FOV: 45 degrees, acquired with a NIDEK AFC-230, 848x848, Davis DR grading:
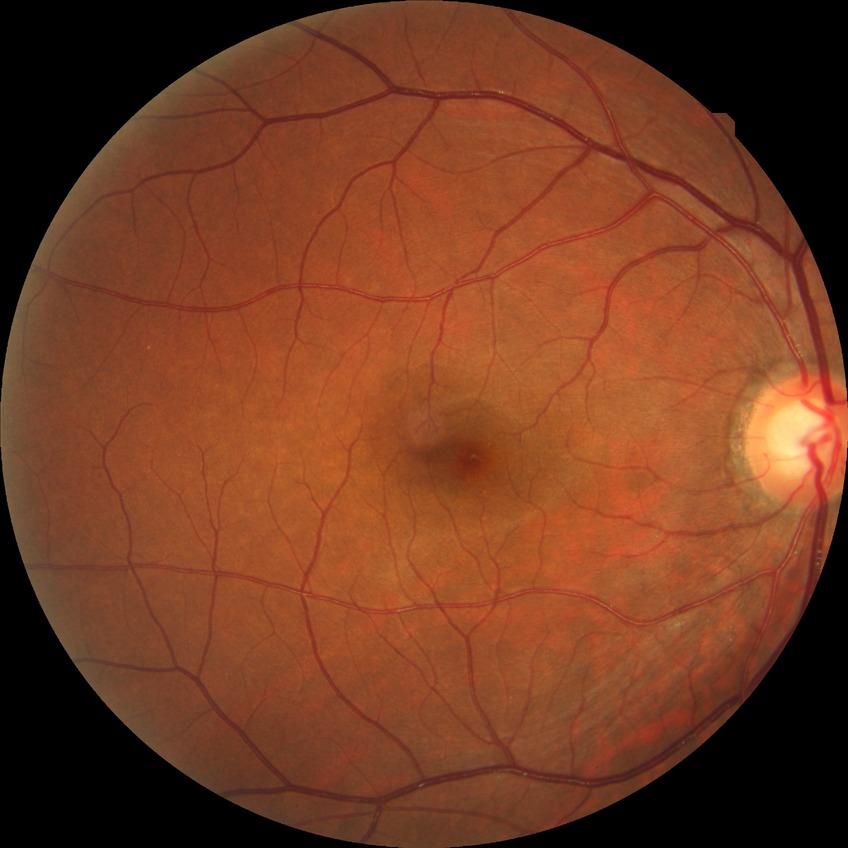

Findings:
• diabetic retinopathy (DR) — NDR (no diabetic retinopathy)